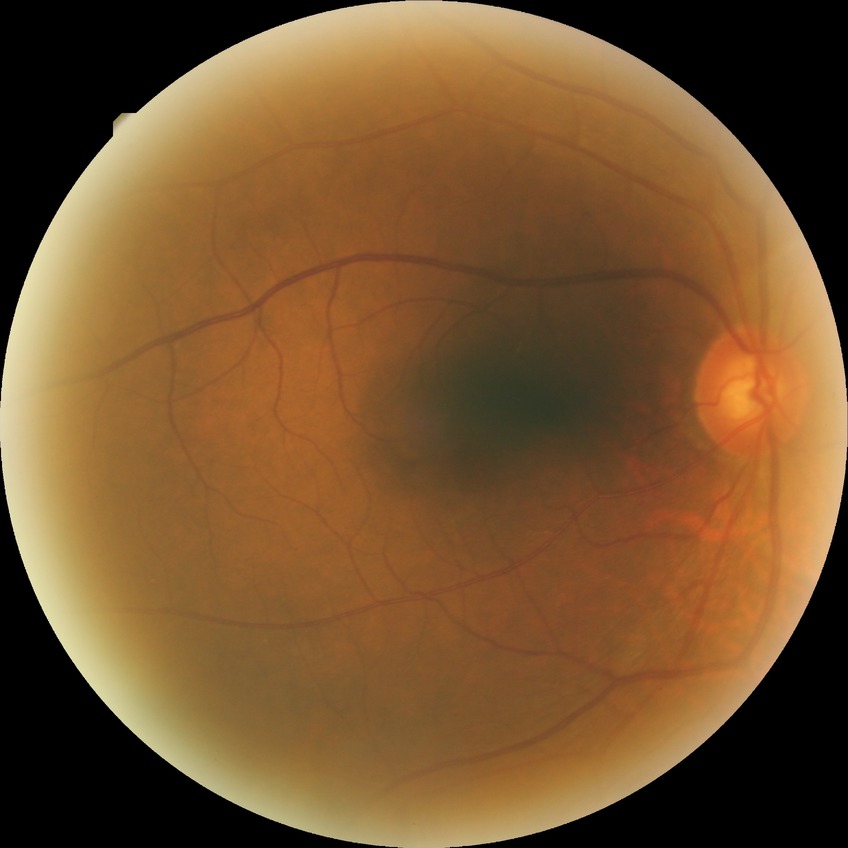
Davis stage is NDR.
No signs of diabetic retinopathy.